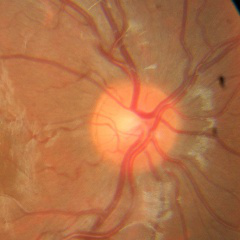 No evidence of glaucoma.